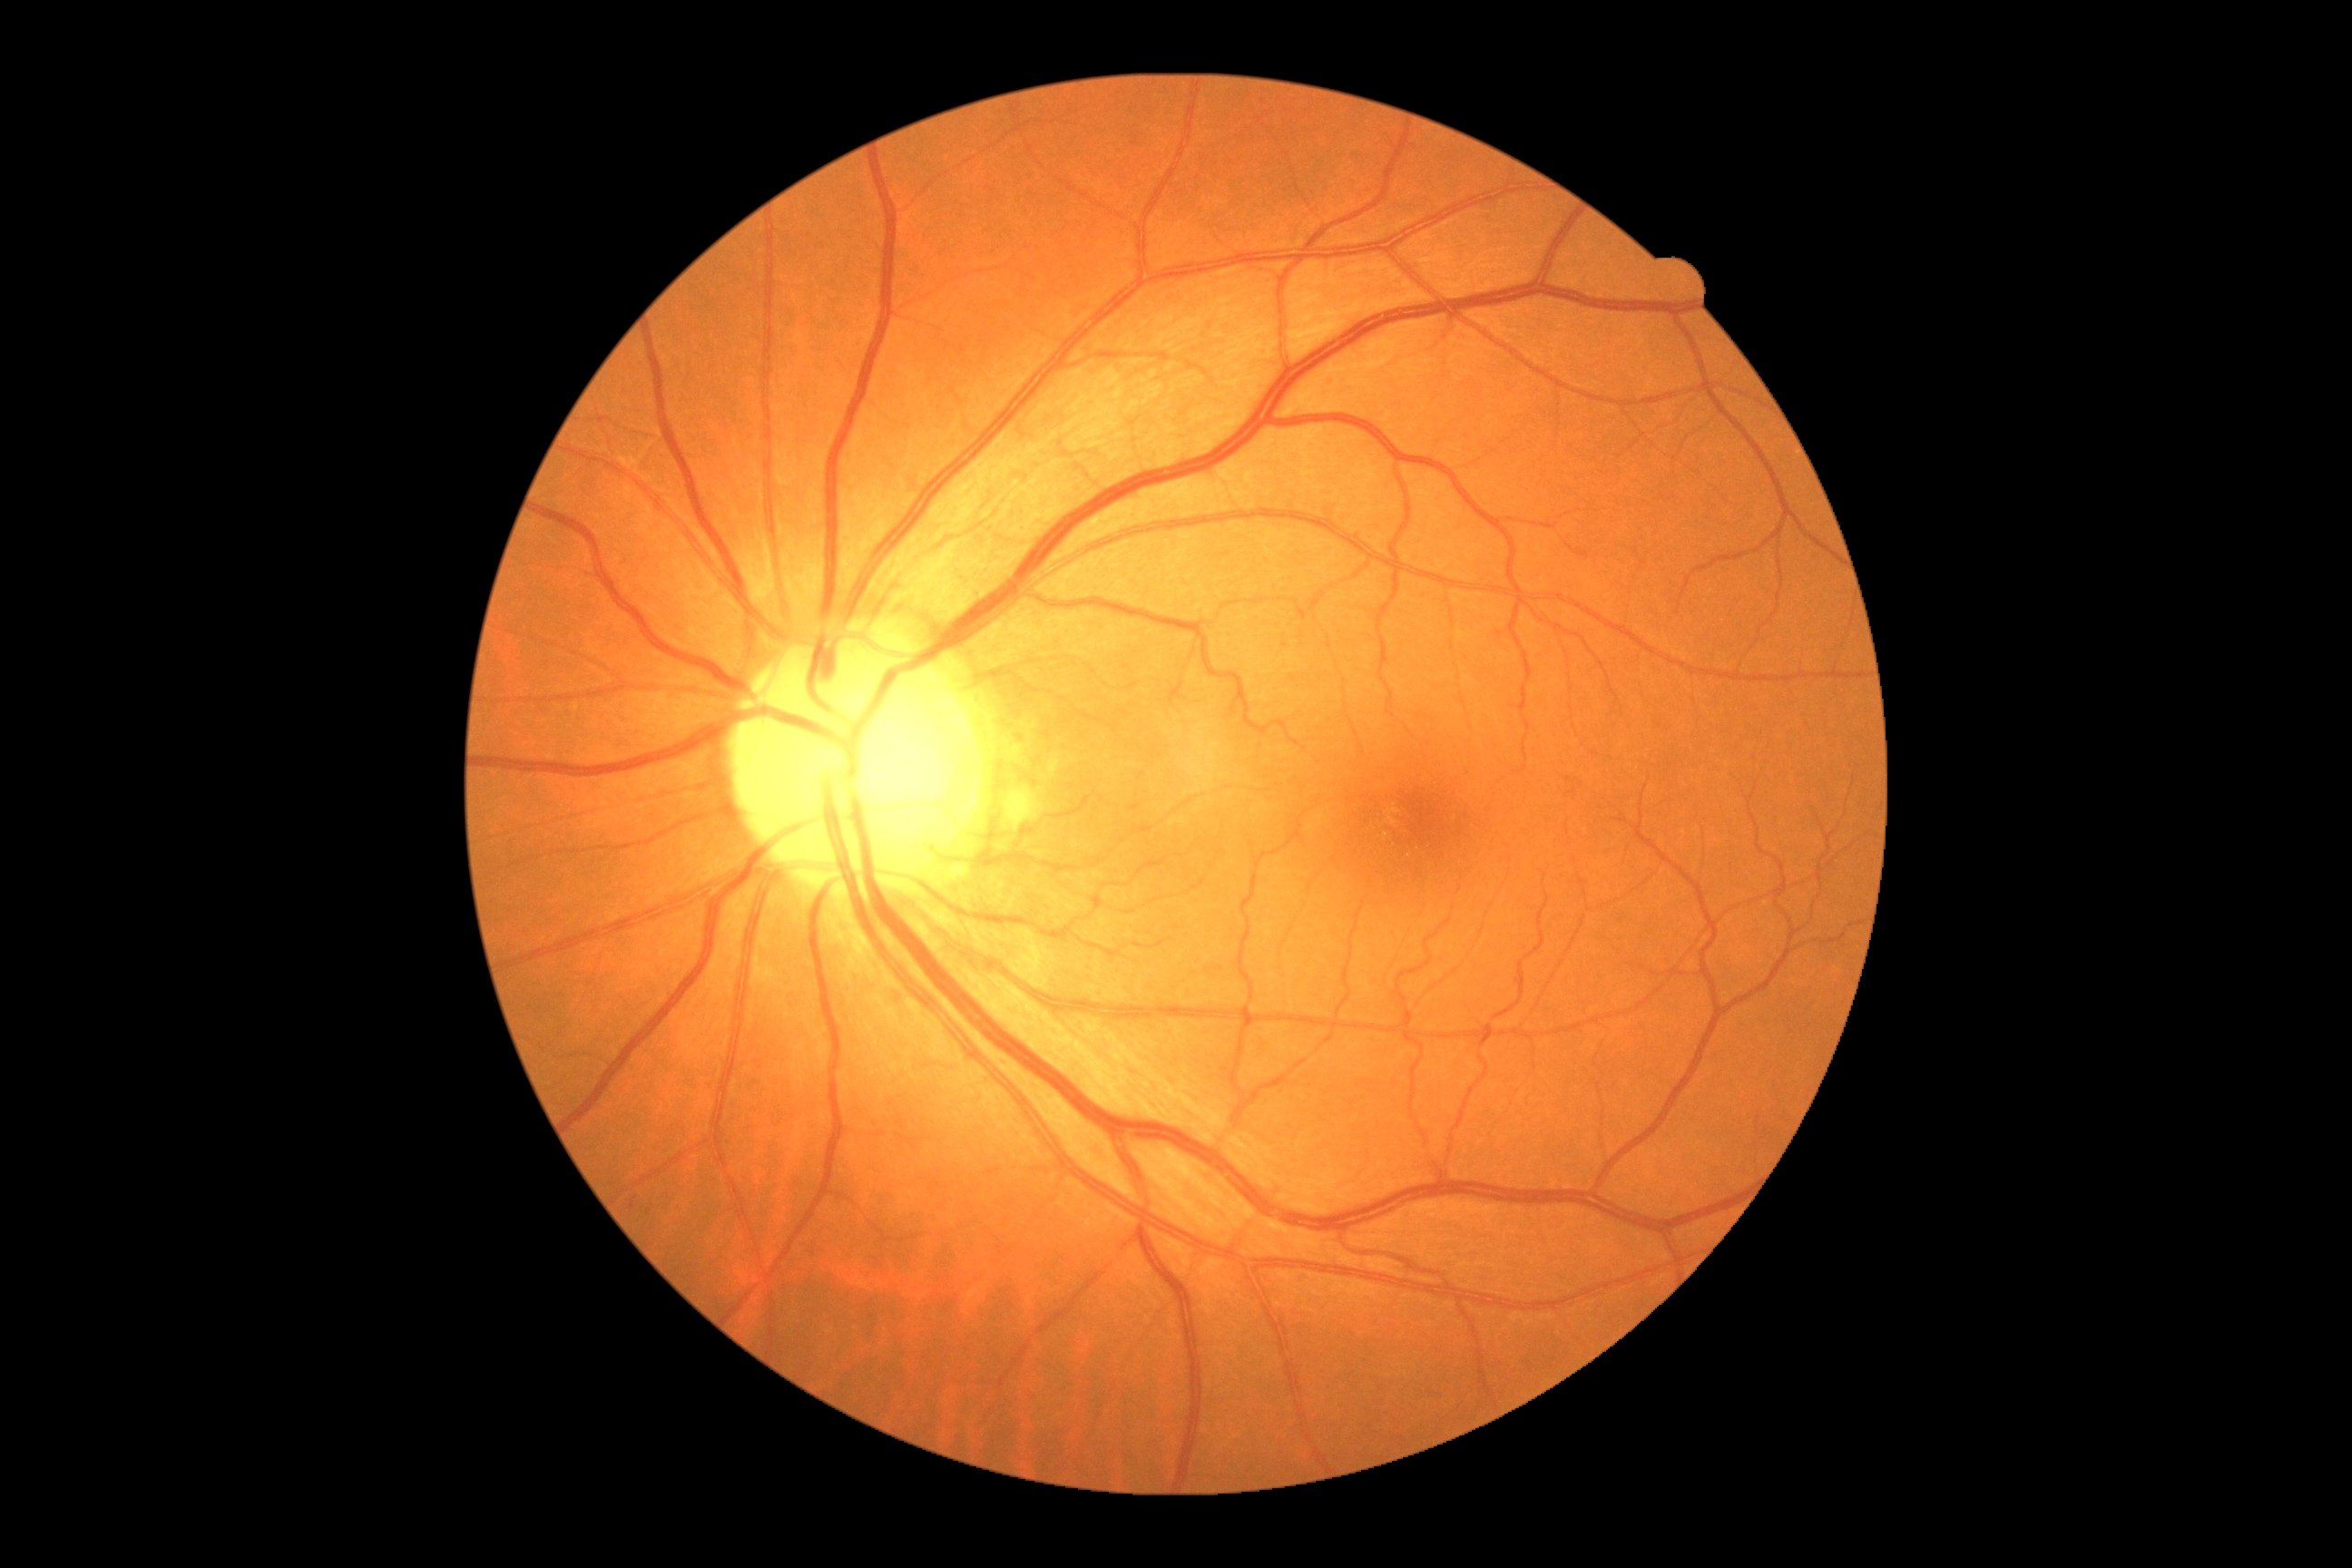

No diabetic retinal disease findings. Retinopathy: 0 — no visible signs of diabetic retinopathy.